Image size 1932x1916: 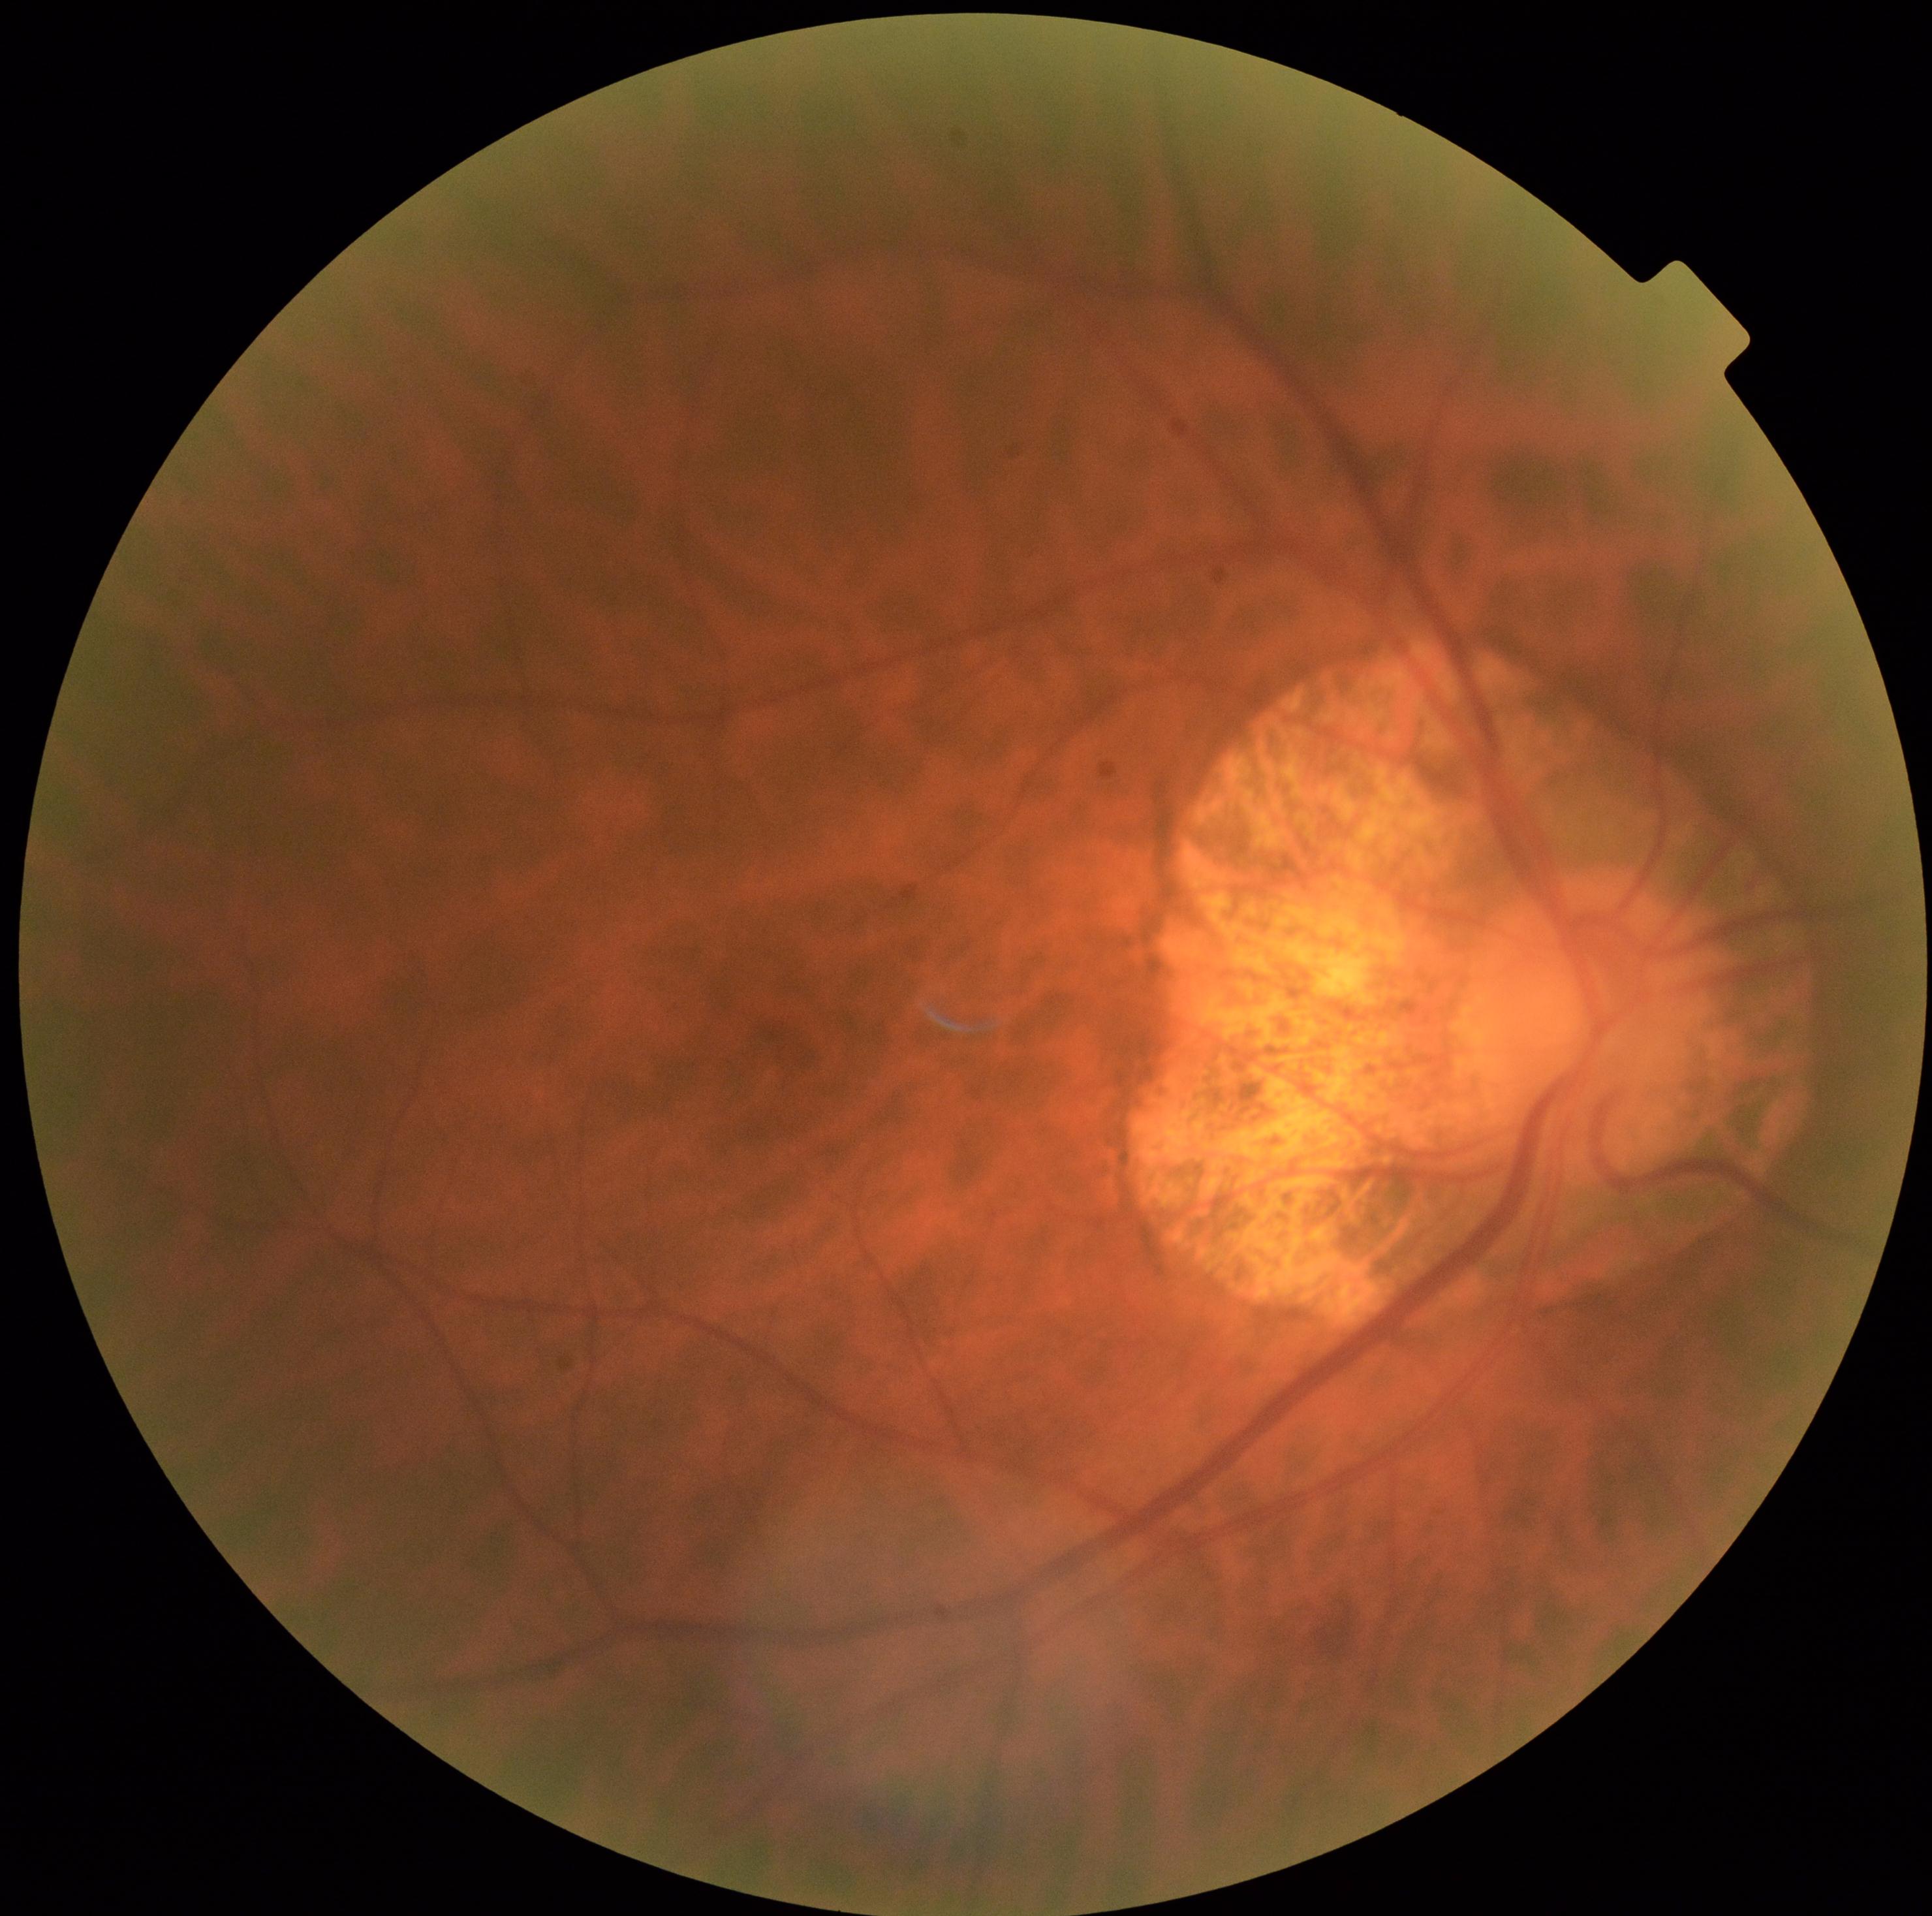 DR severity is 0.